Fundus photo — 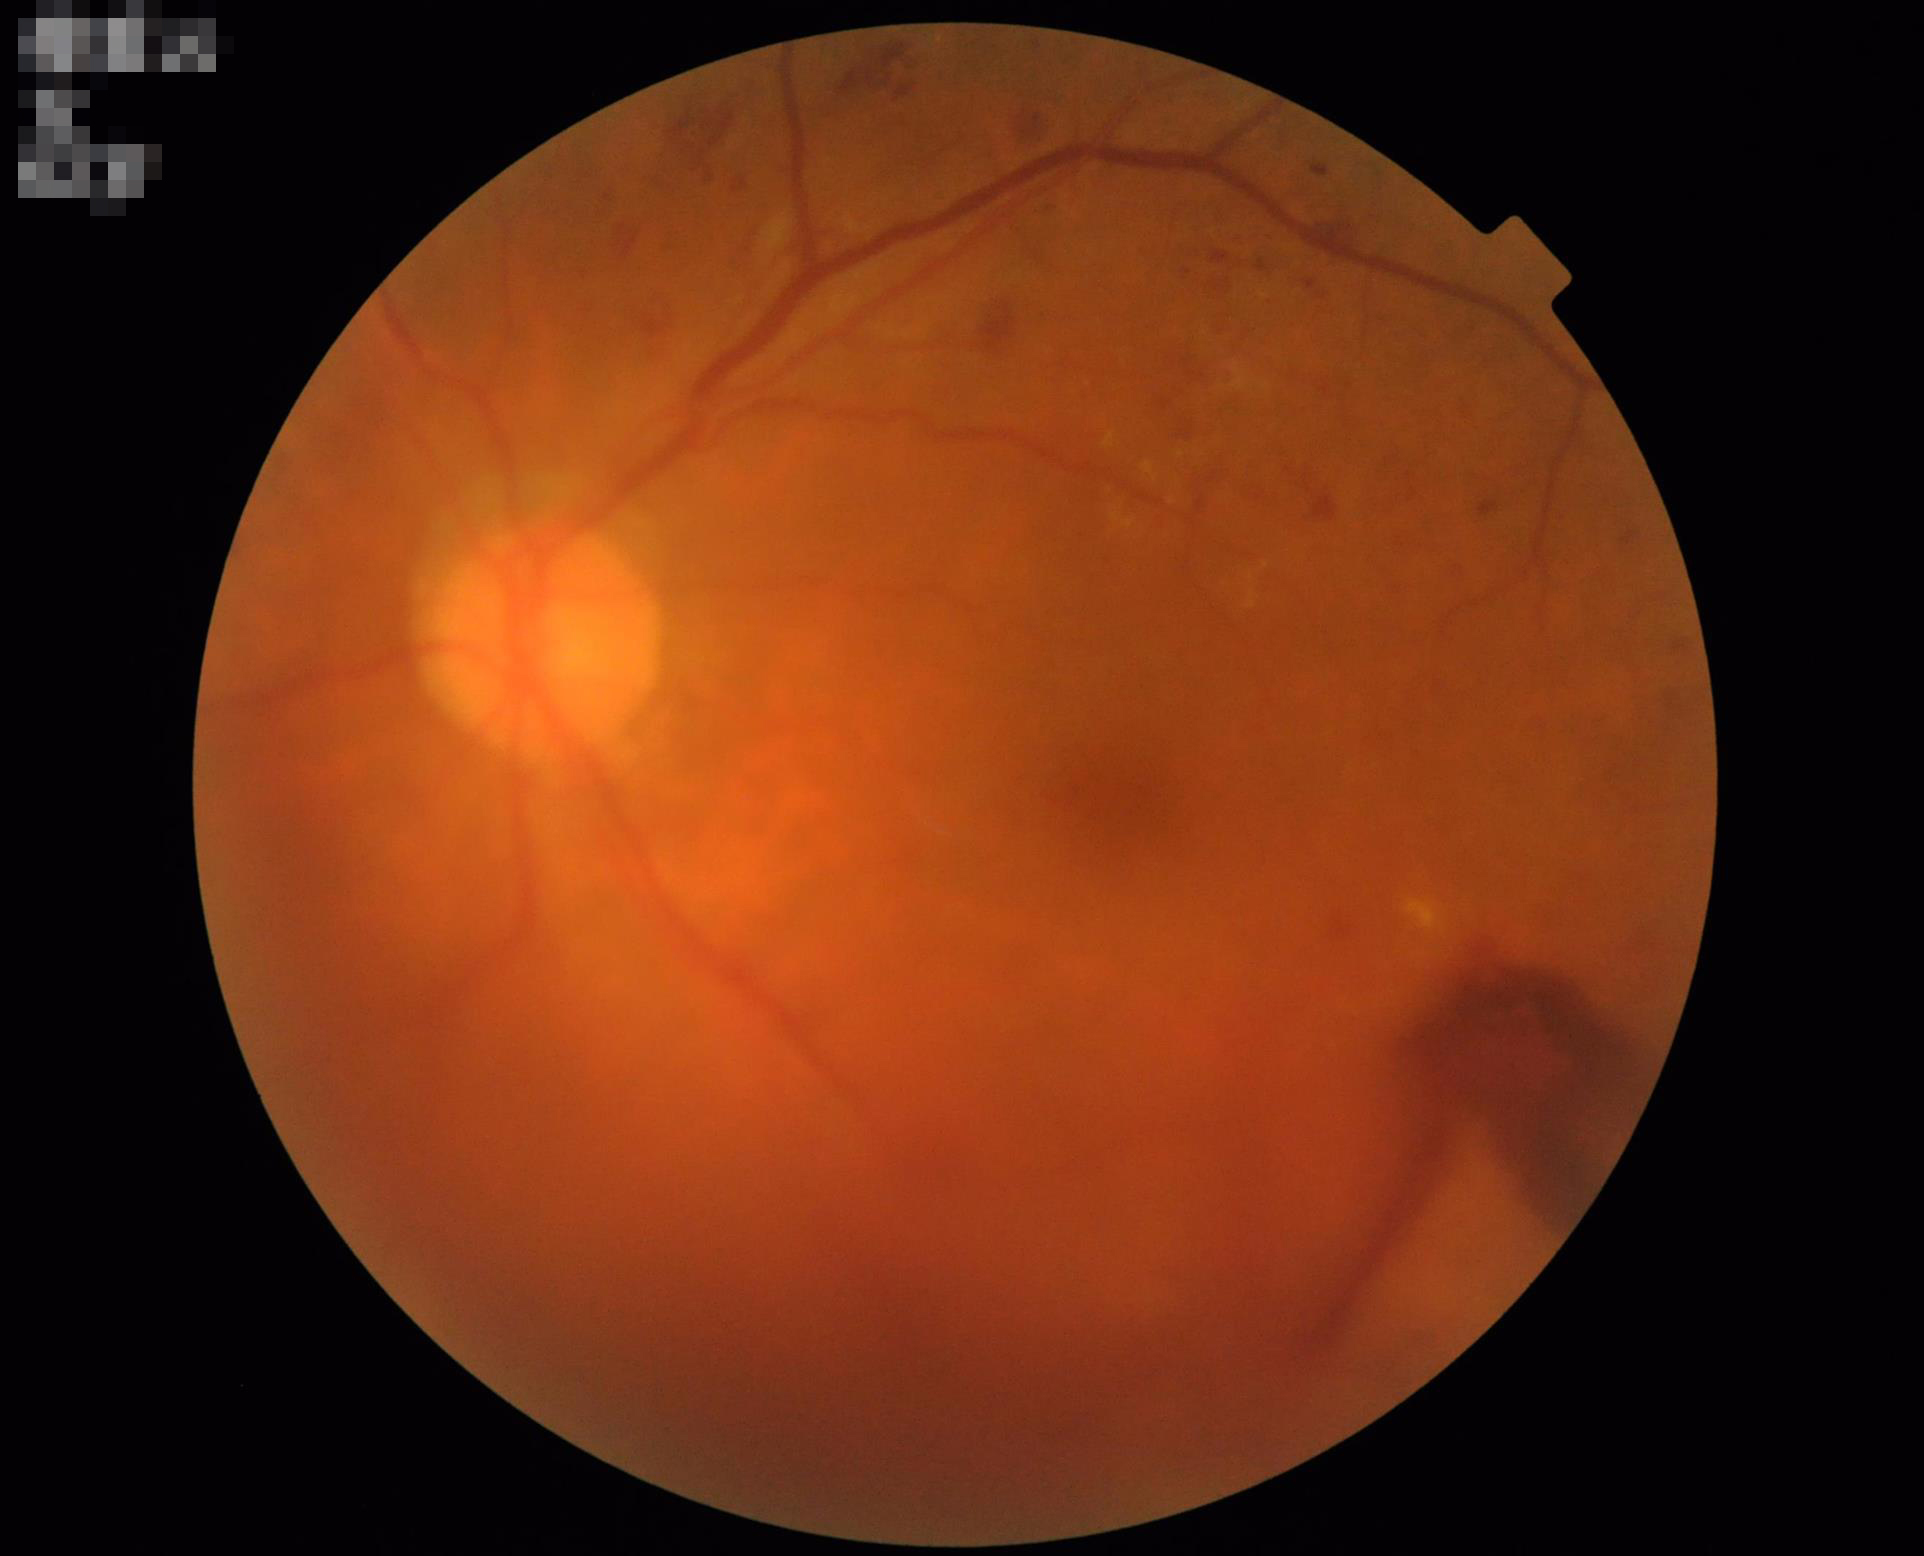
Clarity = out of focus; Illumination/color = adequate; Overall = low; Contrast = good.